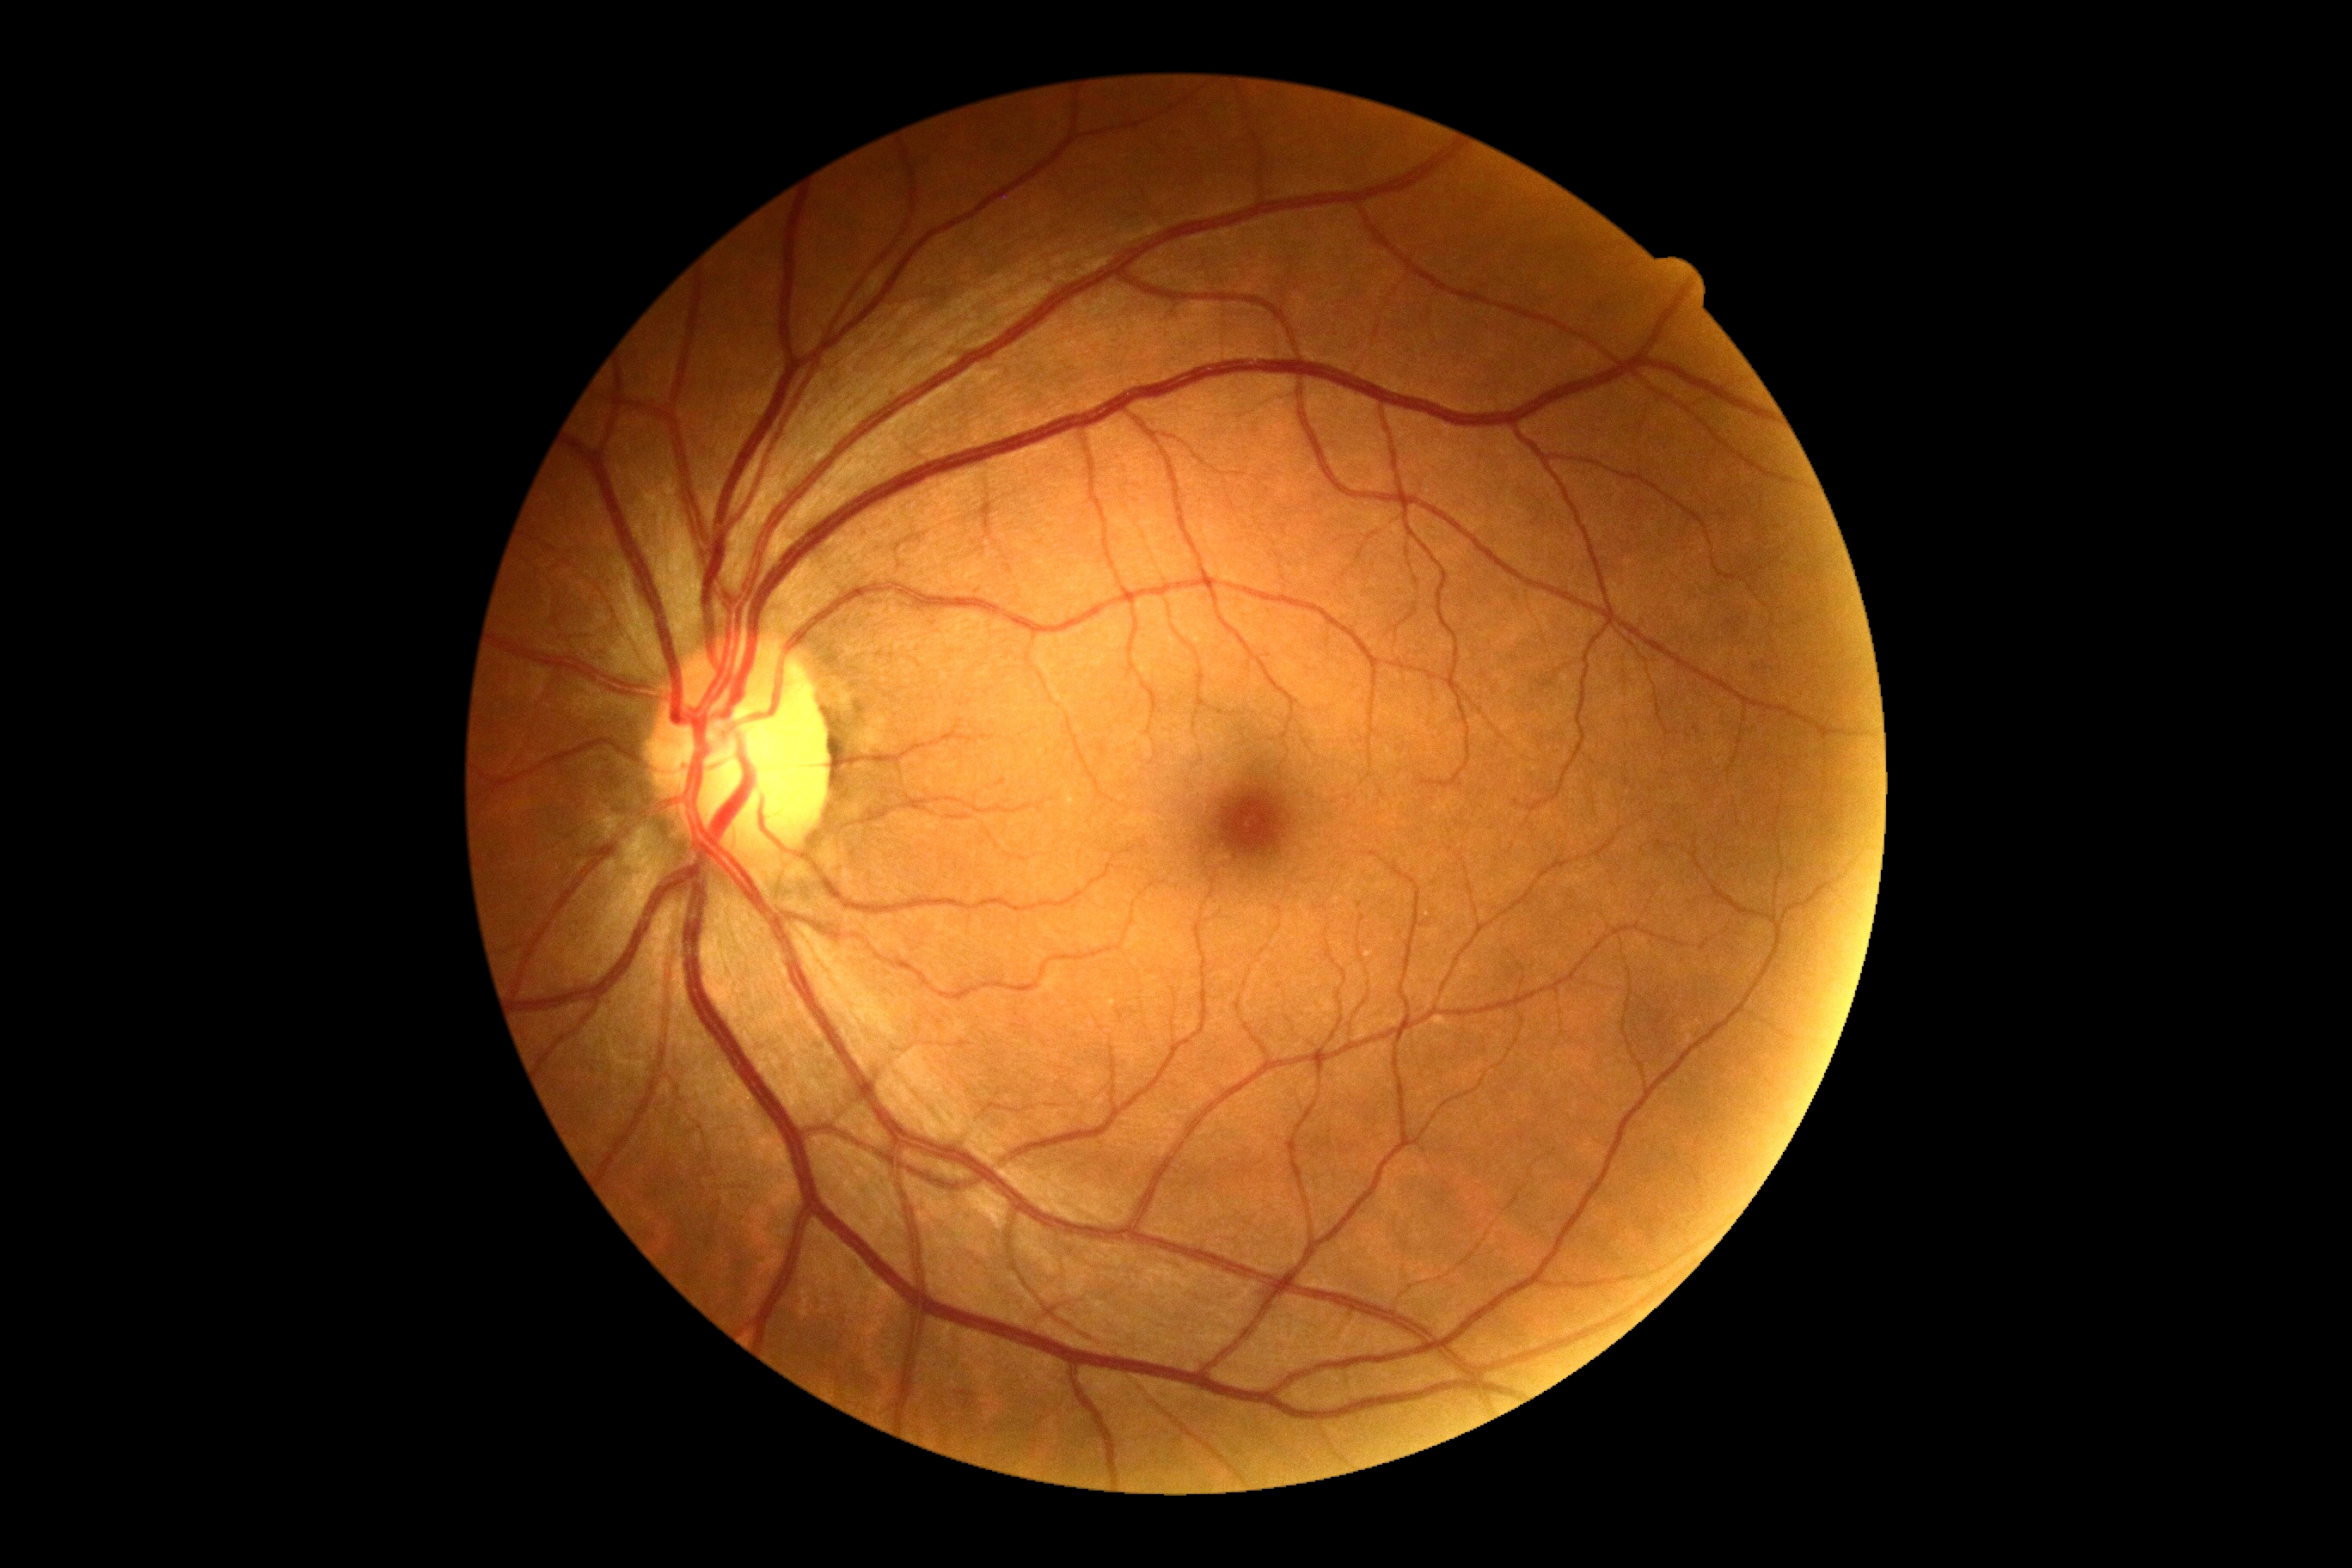

Retinopathy: 0.